Image size 640x480 · acquired on the Clarity RetCam 3 · wide-field fundus photograph of an infant
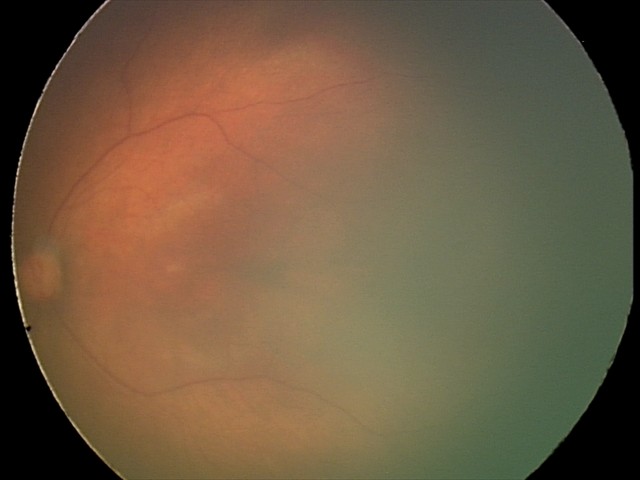 Screening diagnosis: normal fundus examination.